45° field of view, 1932 x 1932 pixels:
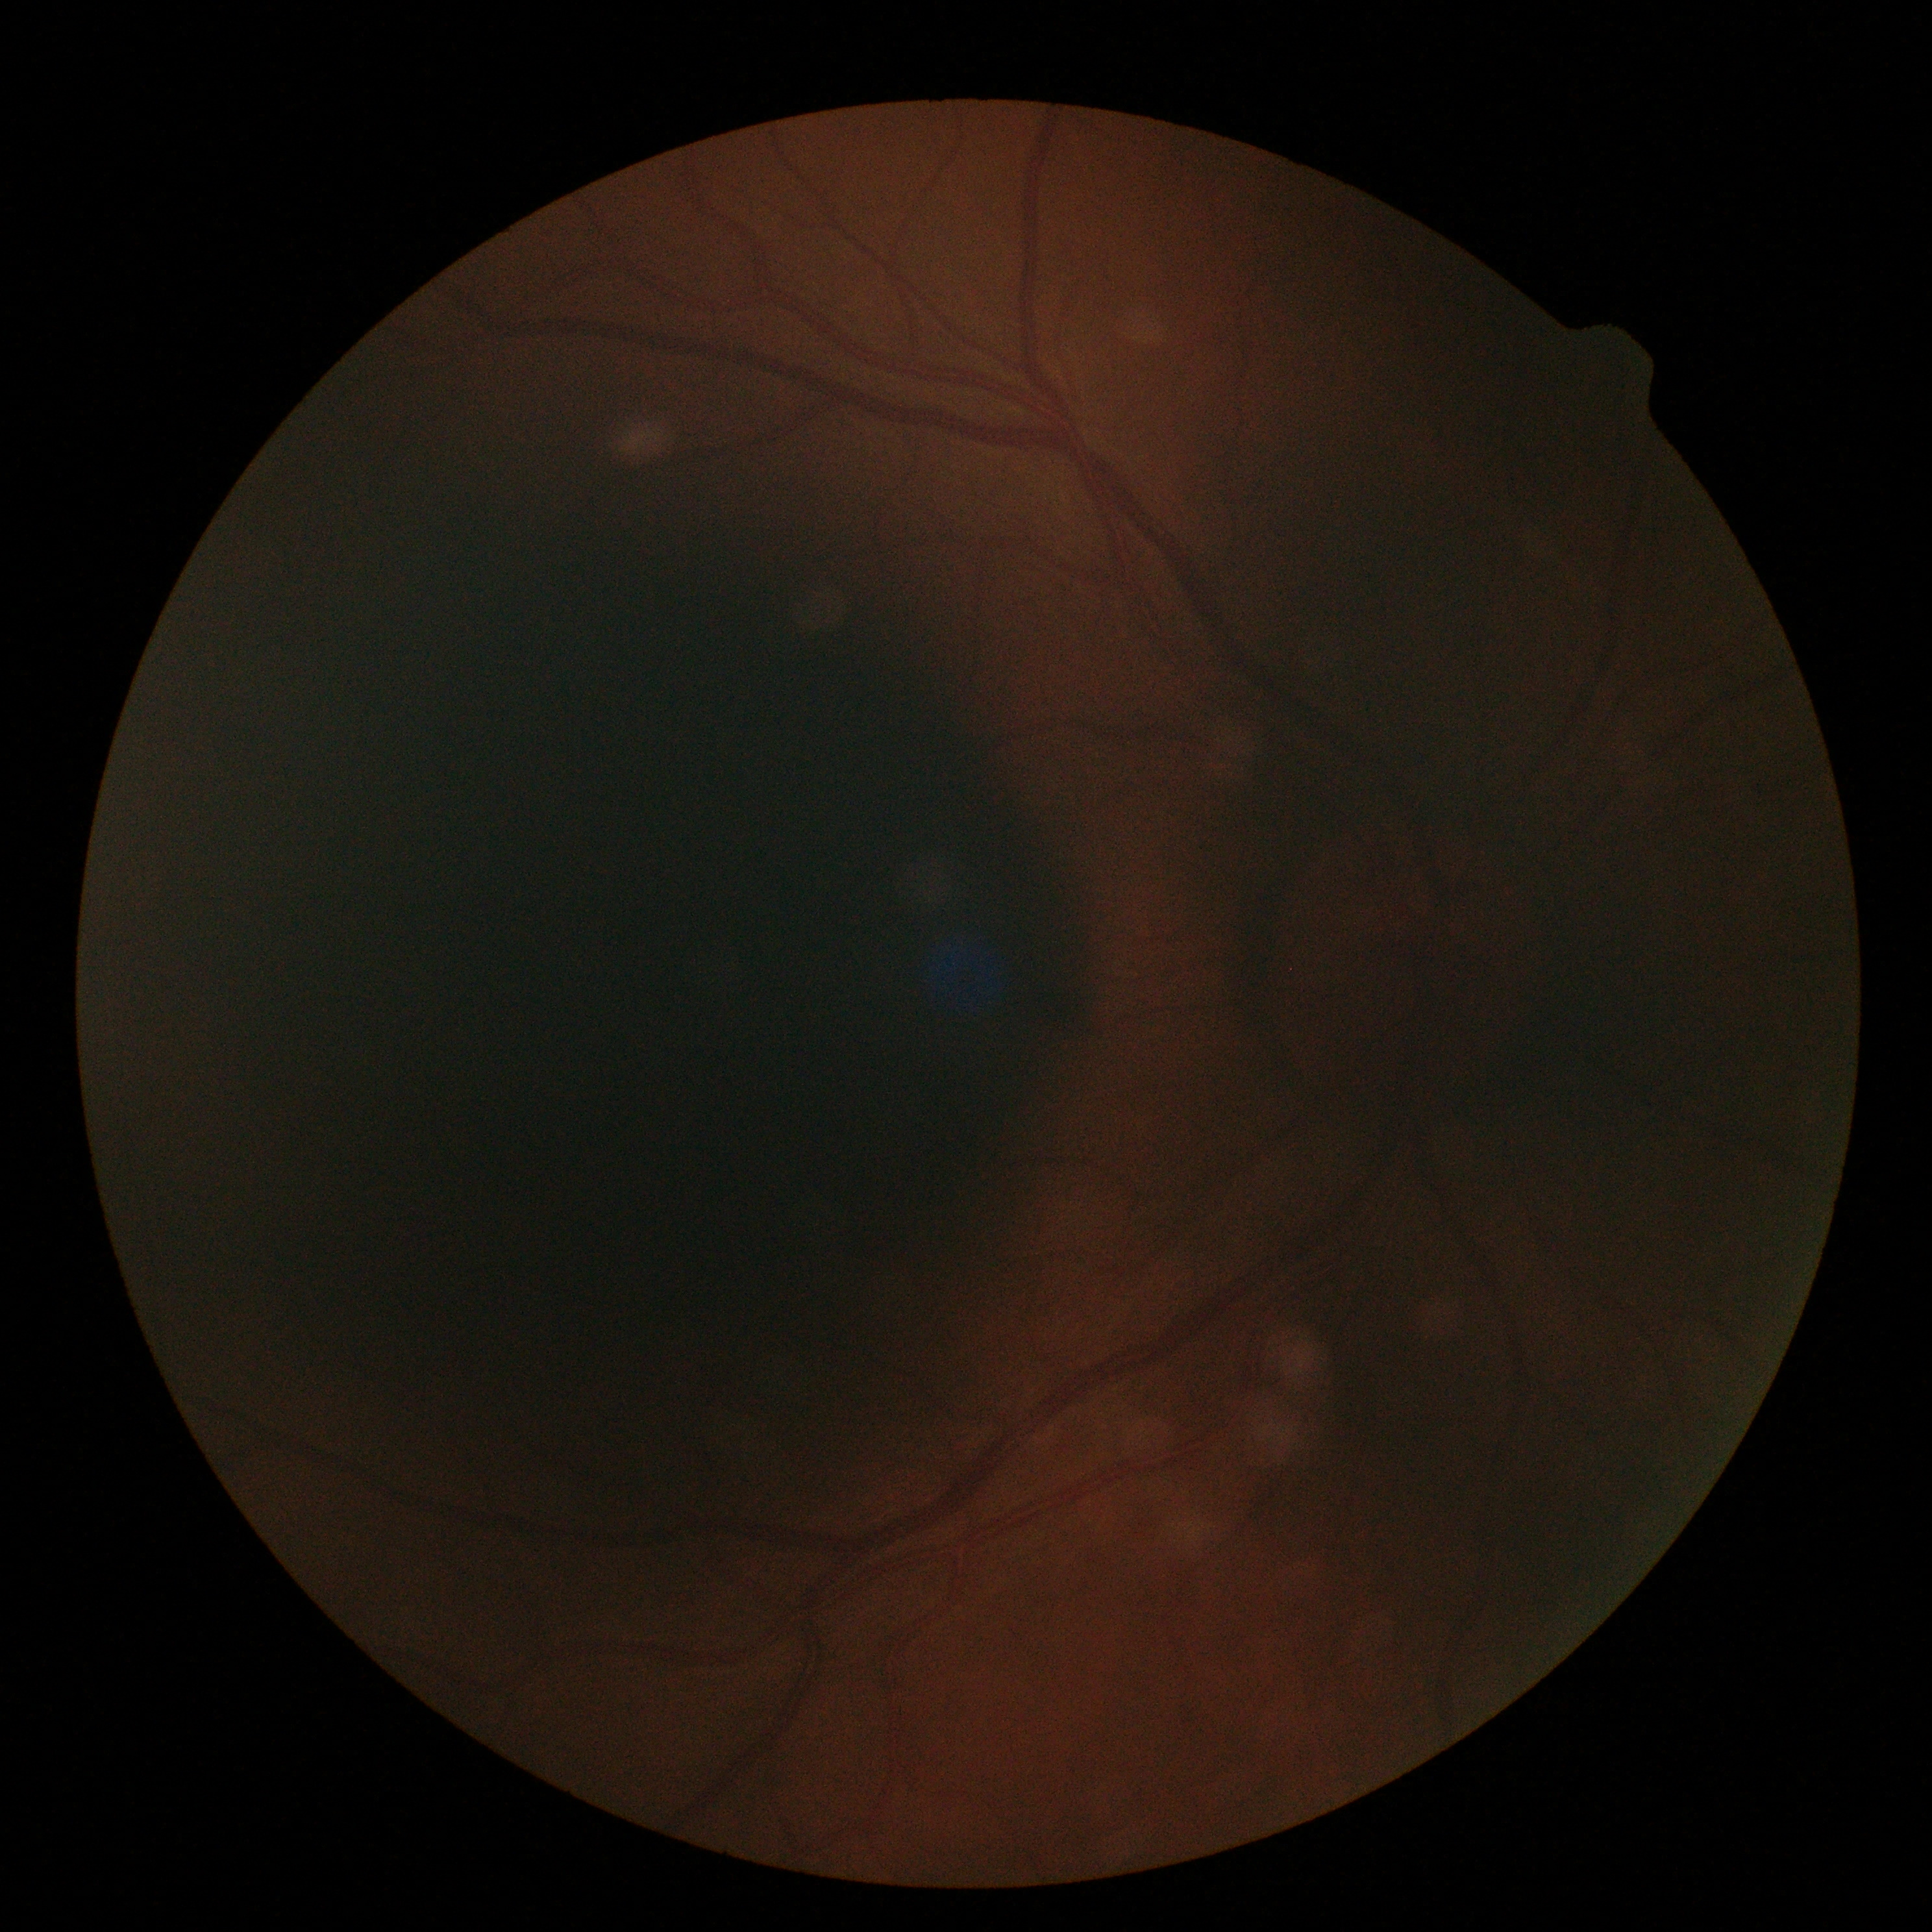 image quality=insufficient for DR assessment; diabetic retinopathy (DR)=ungradable.